Wide-field fundus photograph of an infant:
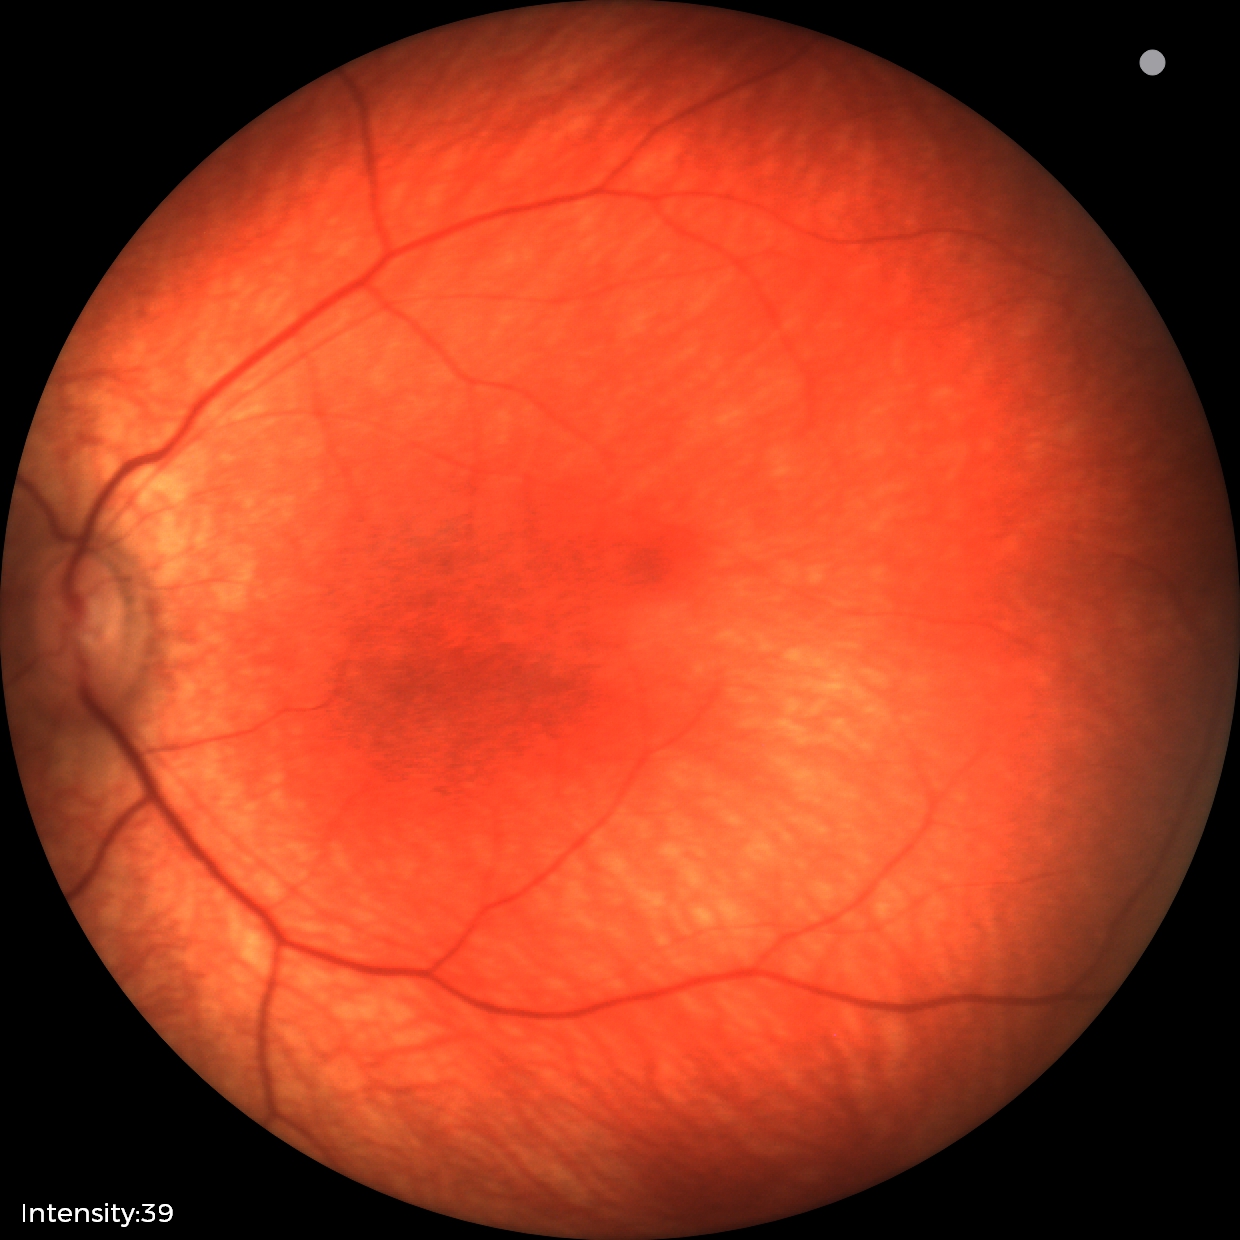
Q: What was the screening finding?
A: normal retinal appearance